Retinal fundus photograph. Image size 2352x1568 — 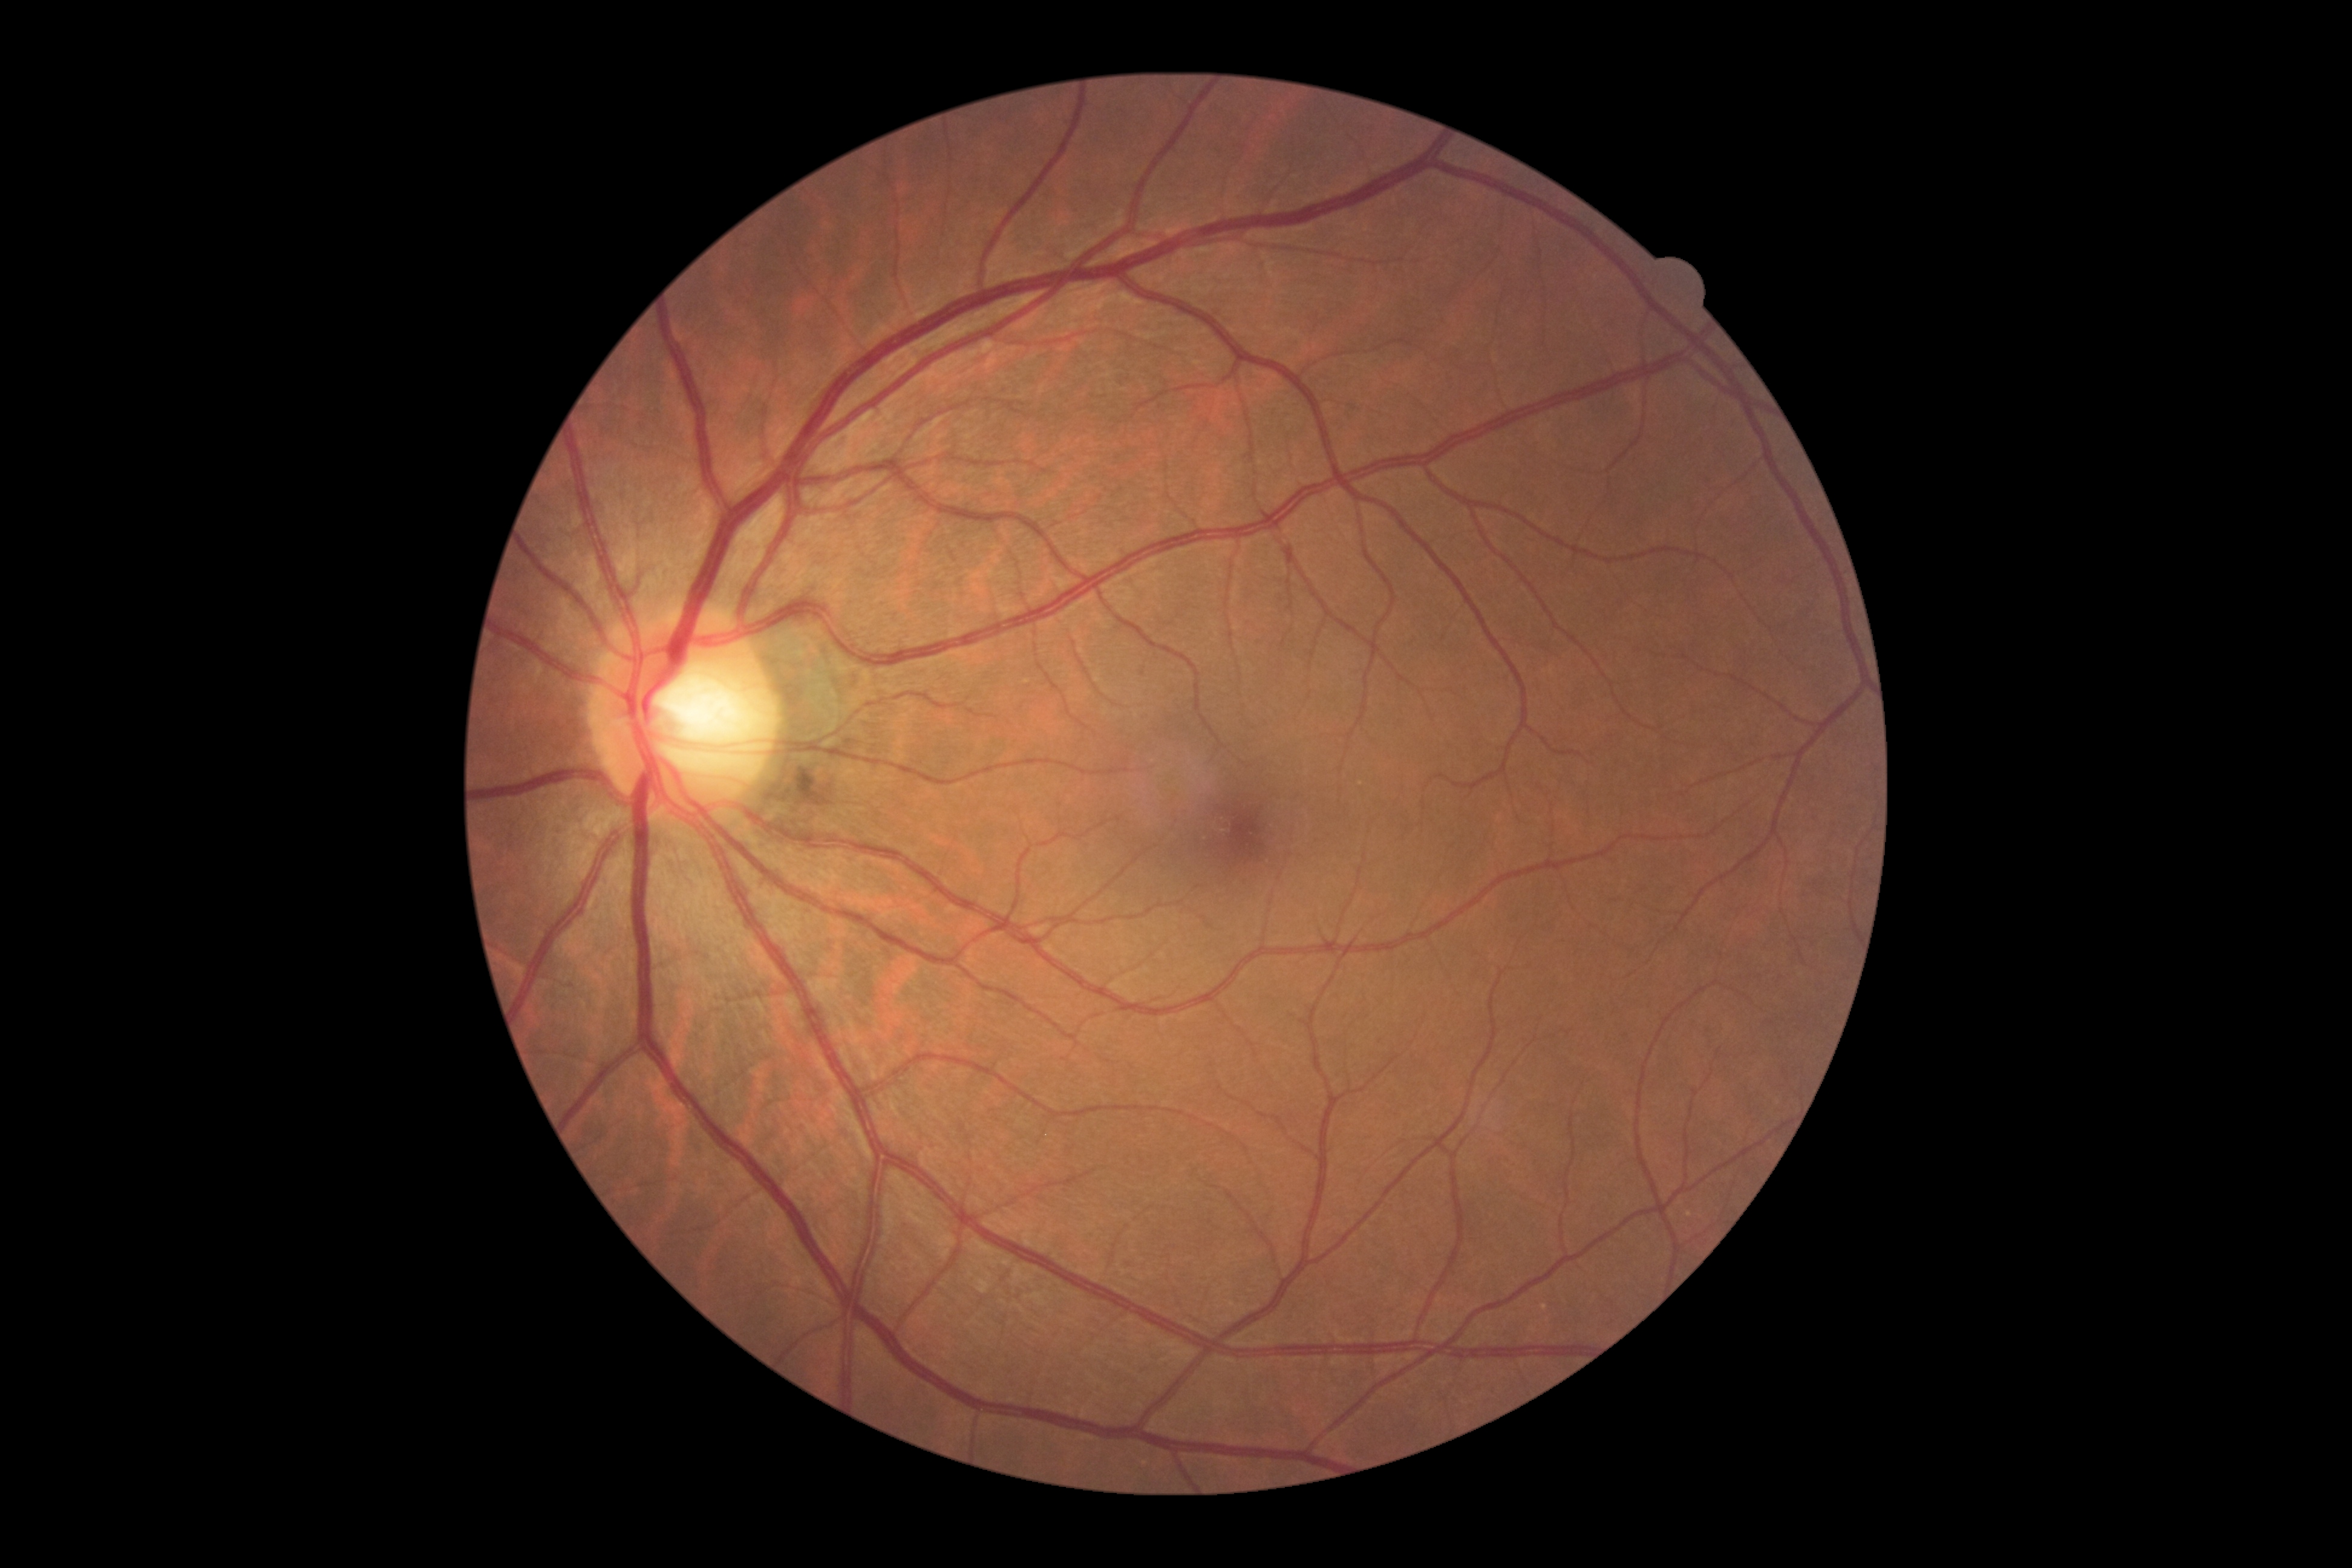
DR severity: grade 0 (no apparent retinopathy).